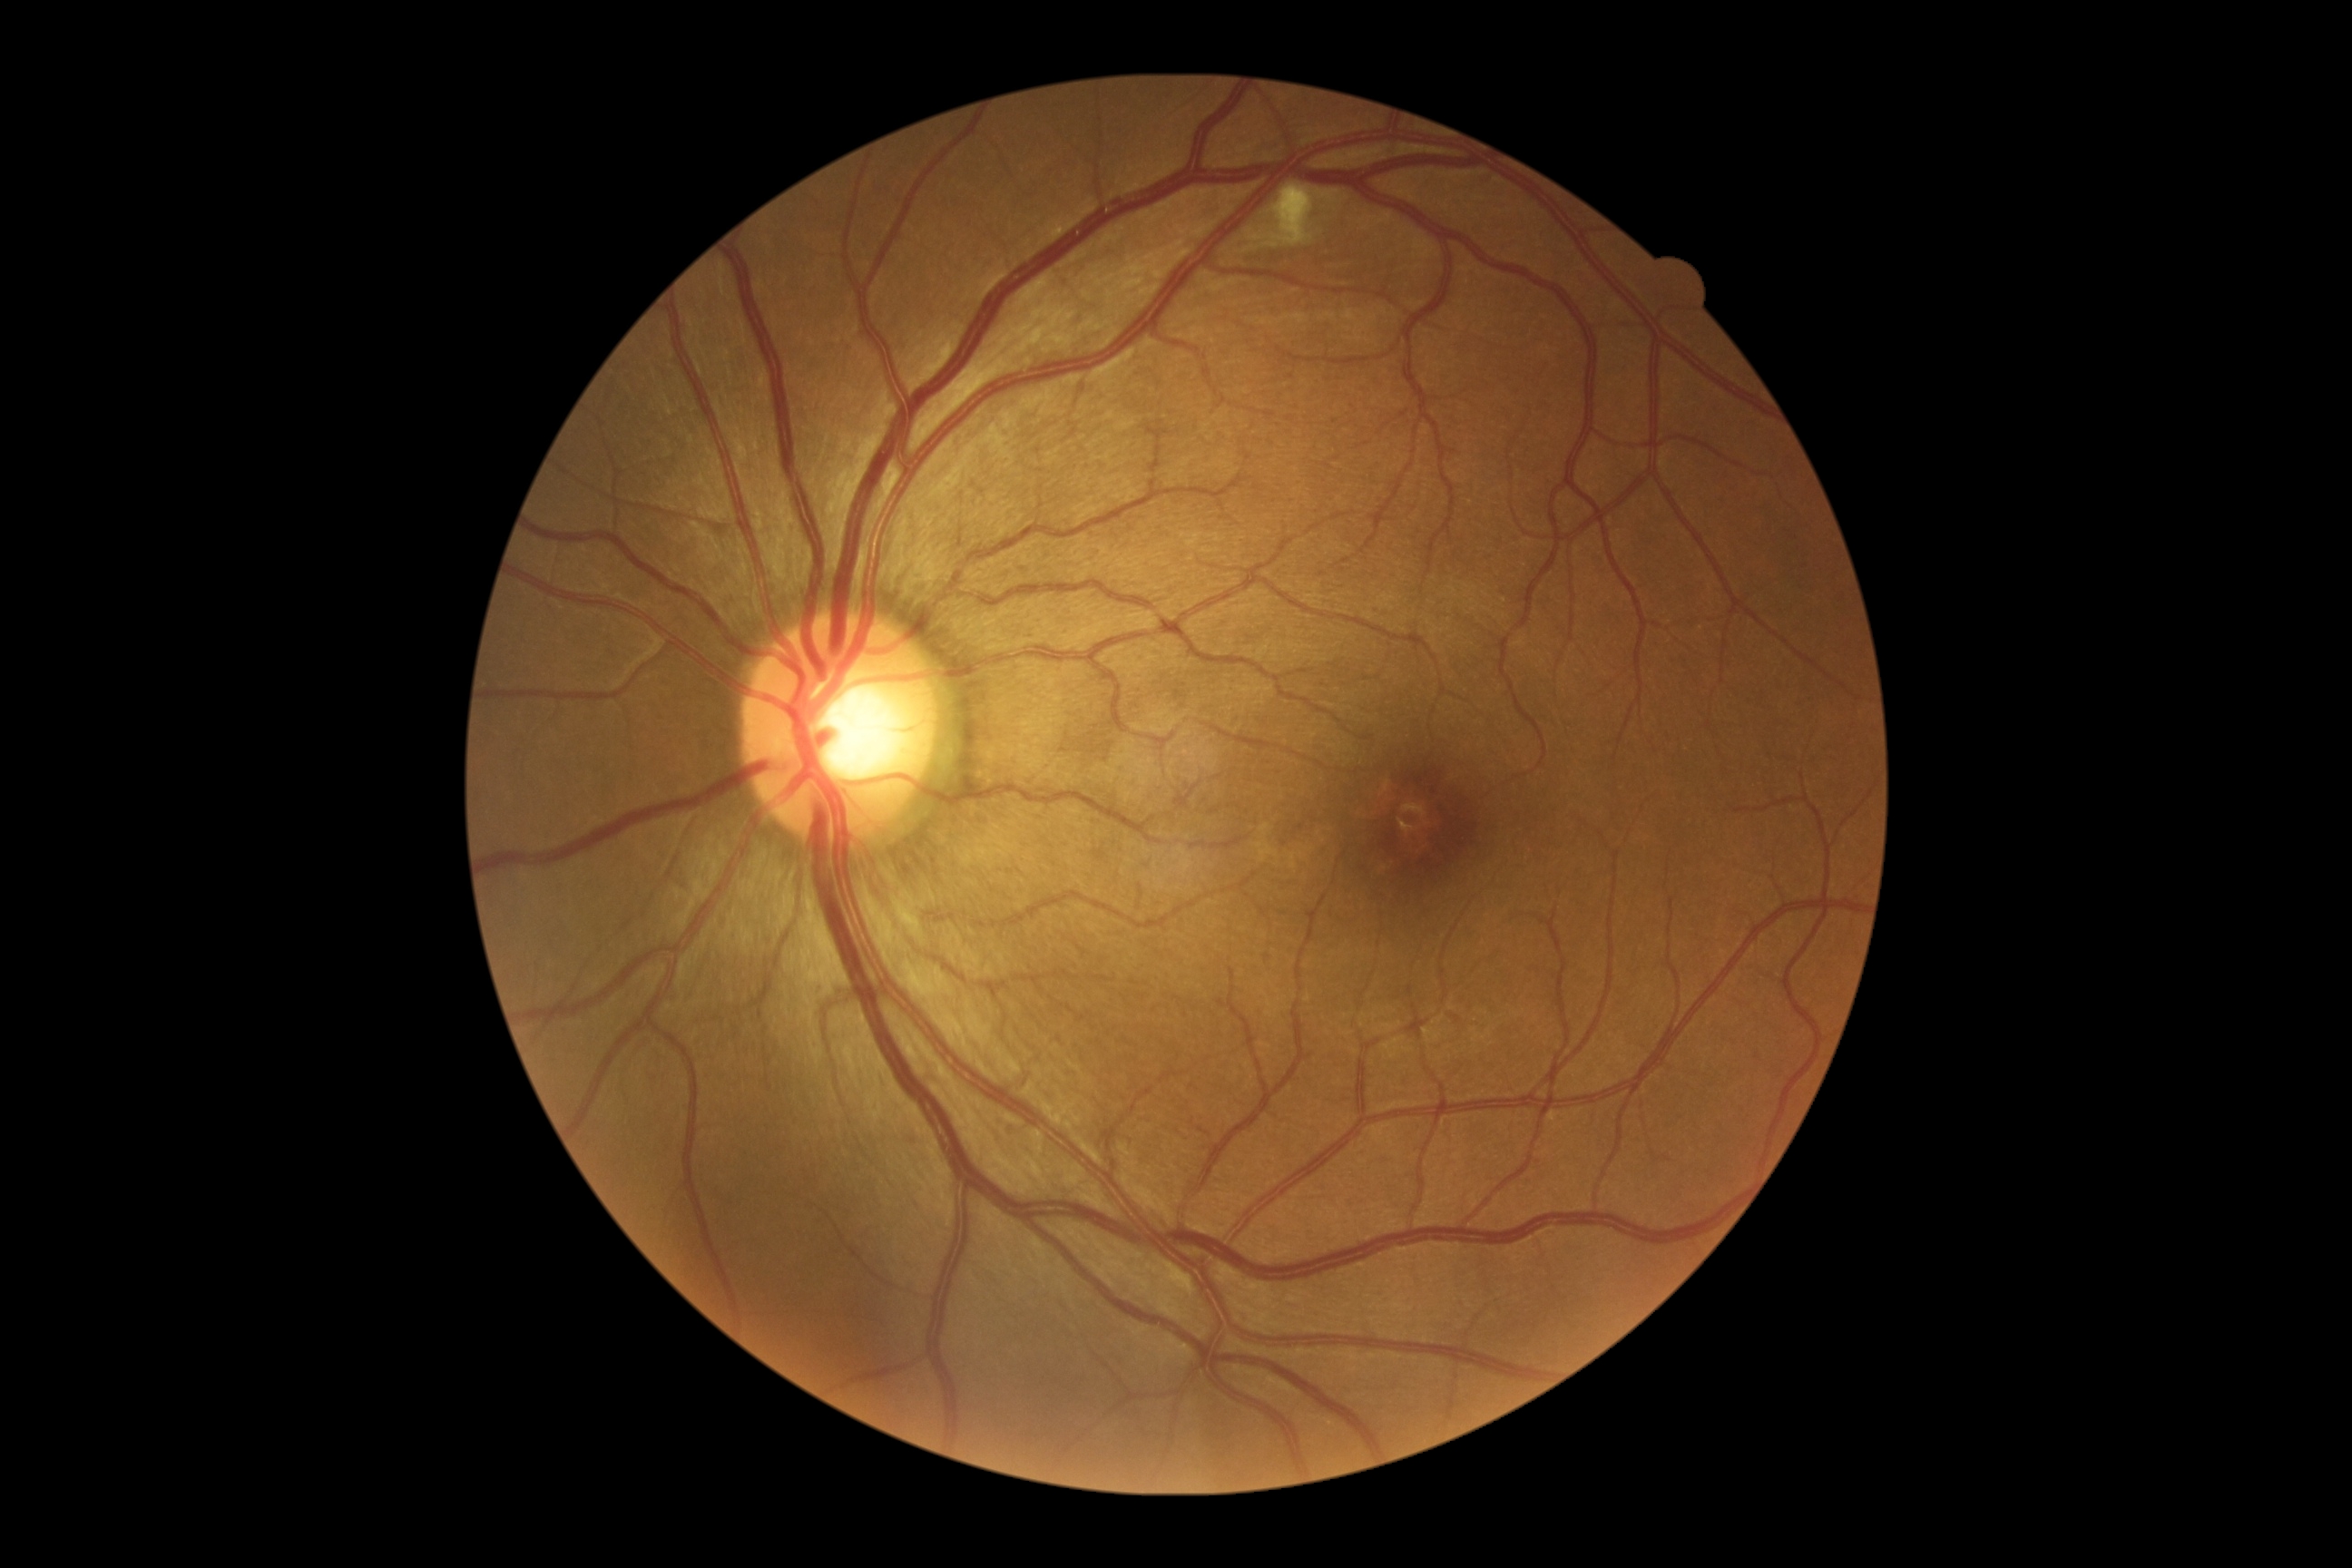 diabetic retinopathy (DR): grade 2 (moderate NPDR)